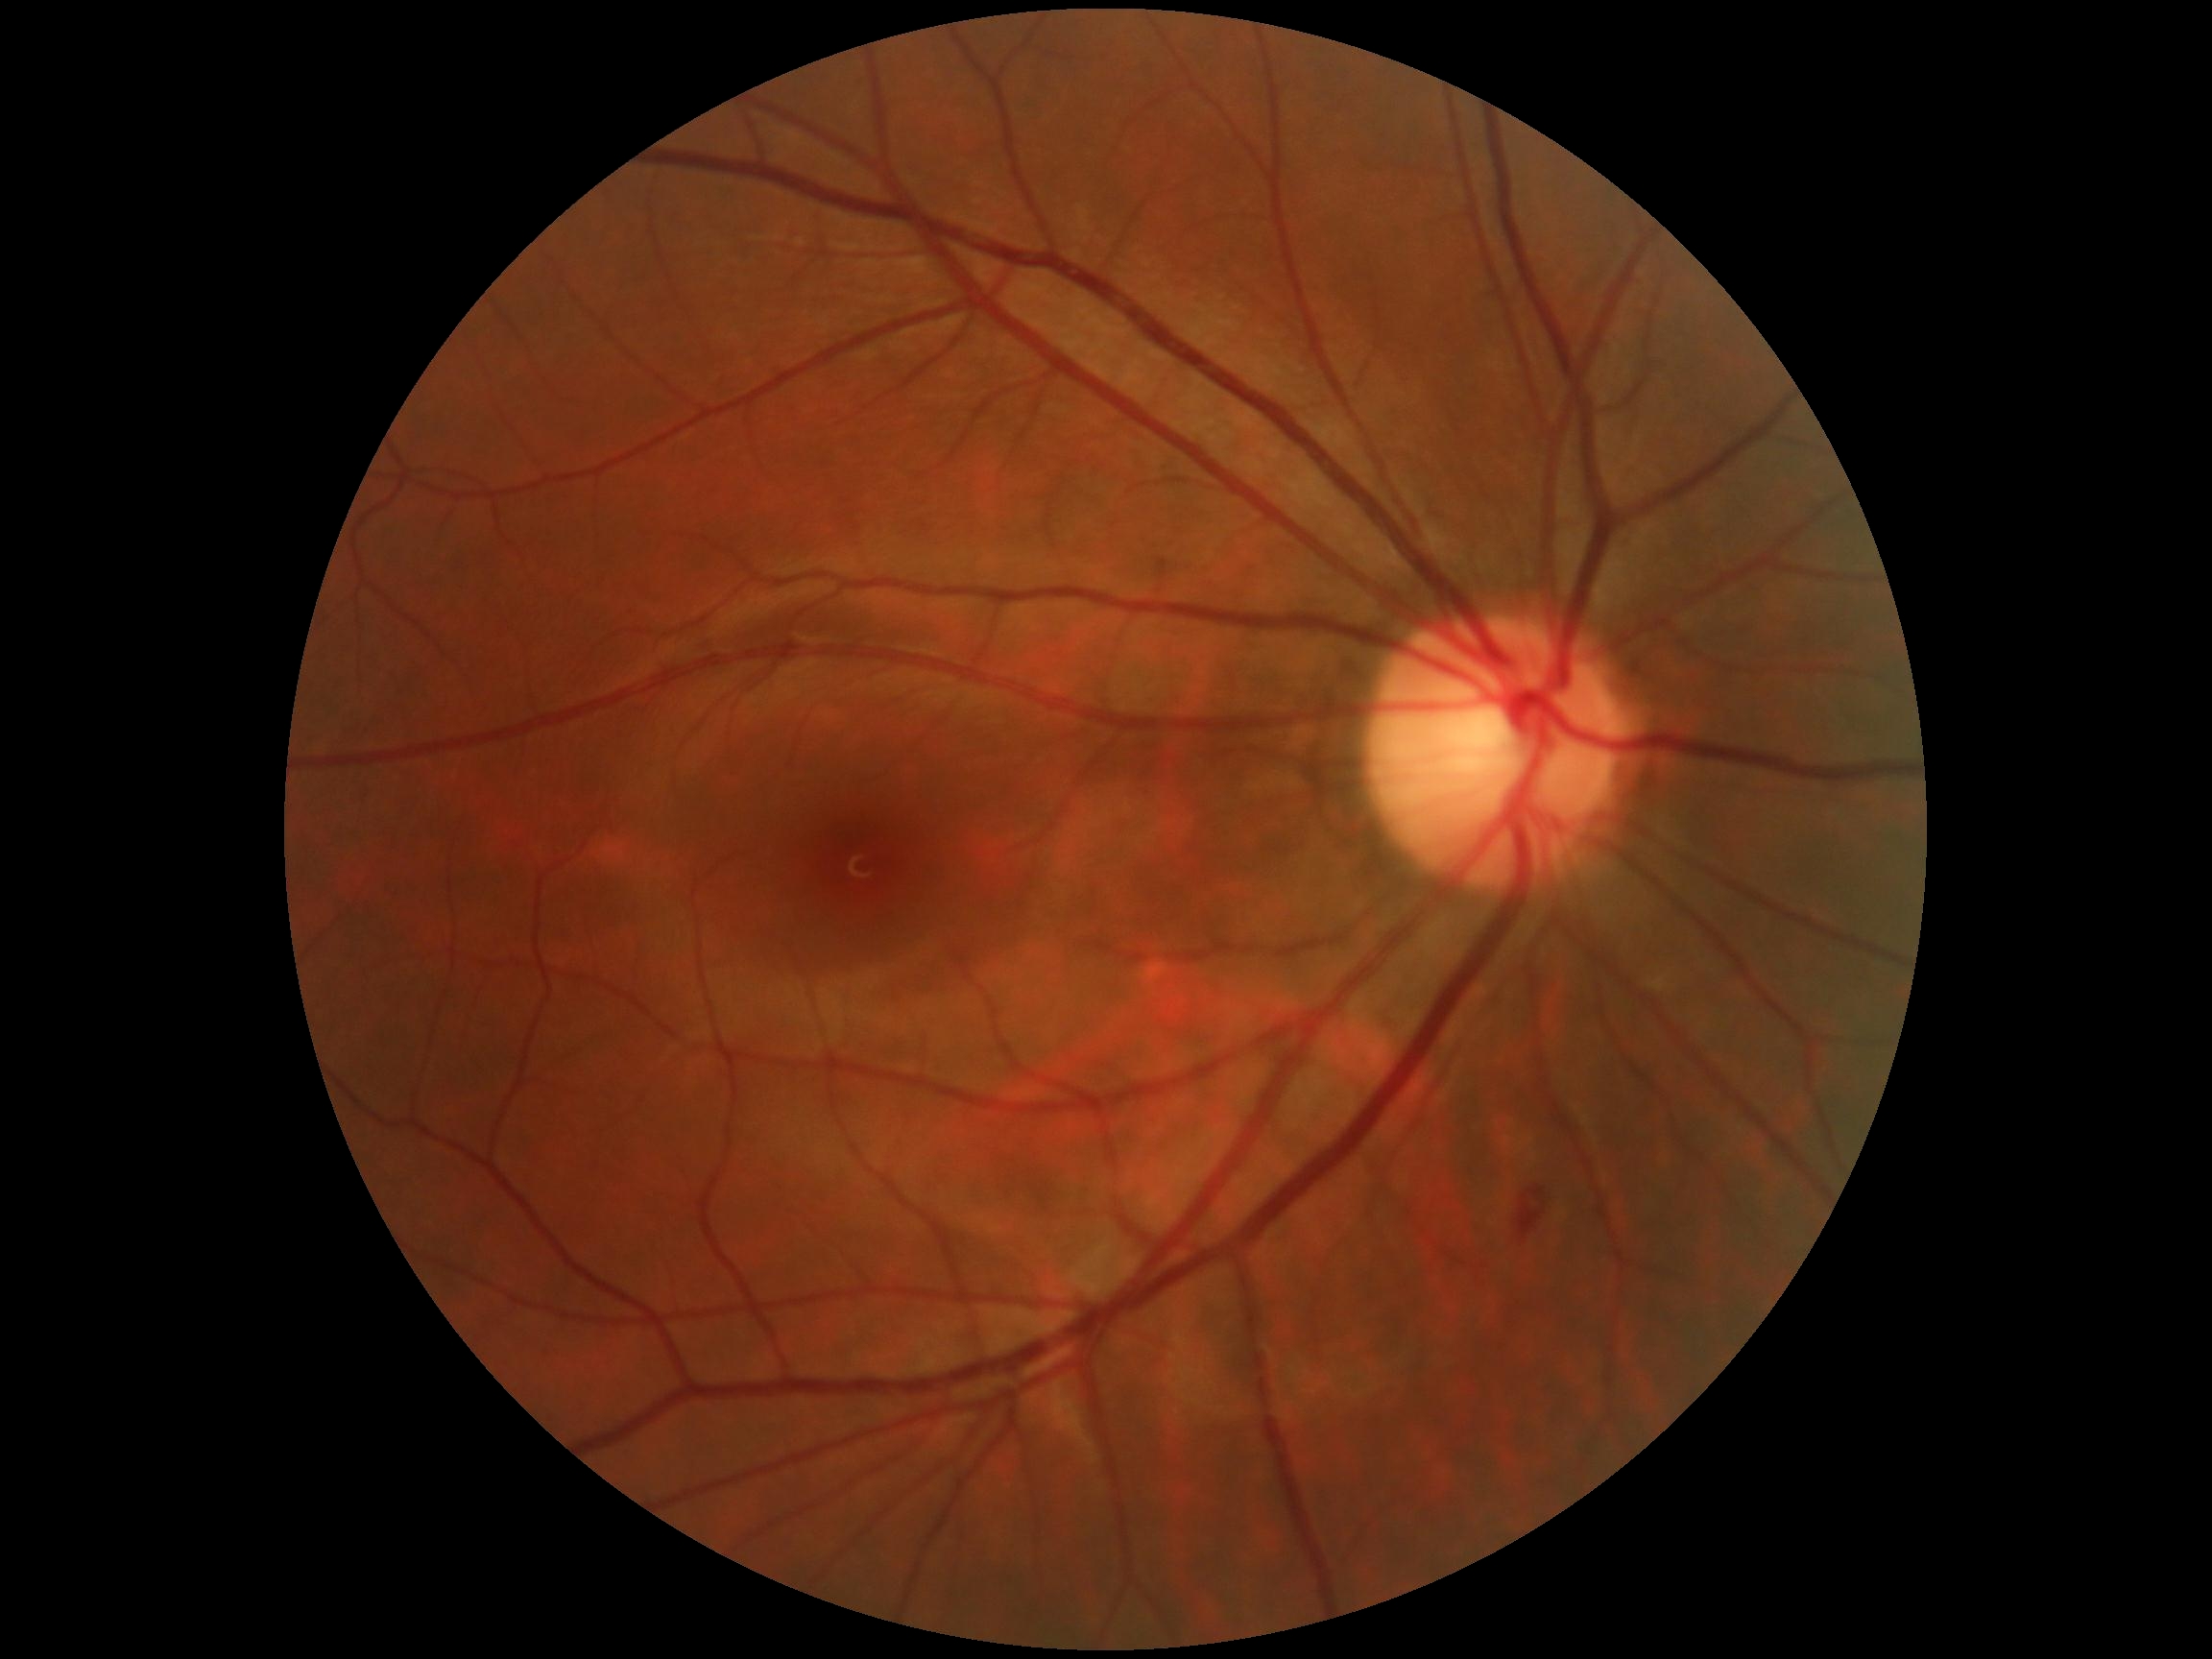 The retinopathy is classified as non-proliferative diabetic retinopathy.
Diabetic retinopathy severity: grade 2 (moderate NPDR).